Color fundus image · 45° field of view · 2352x1568px — 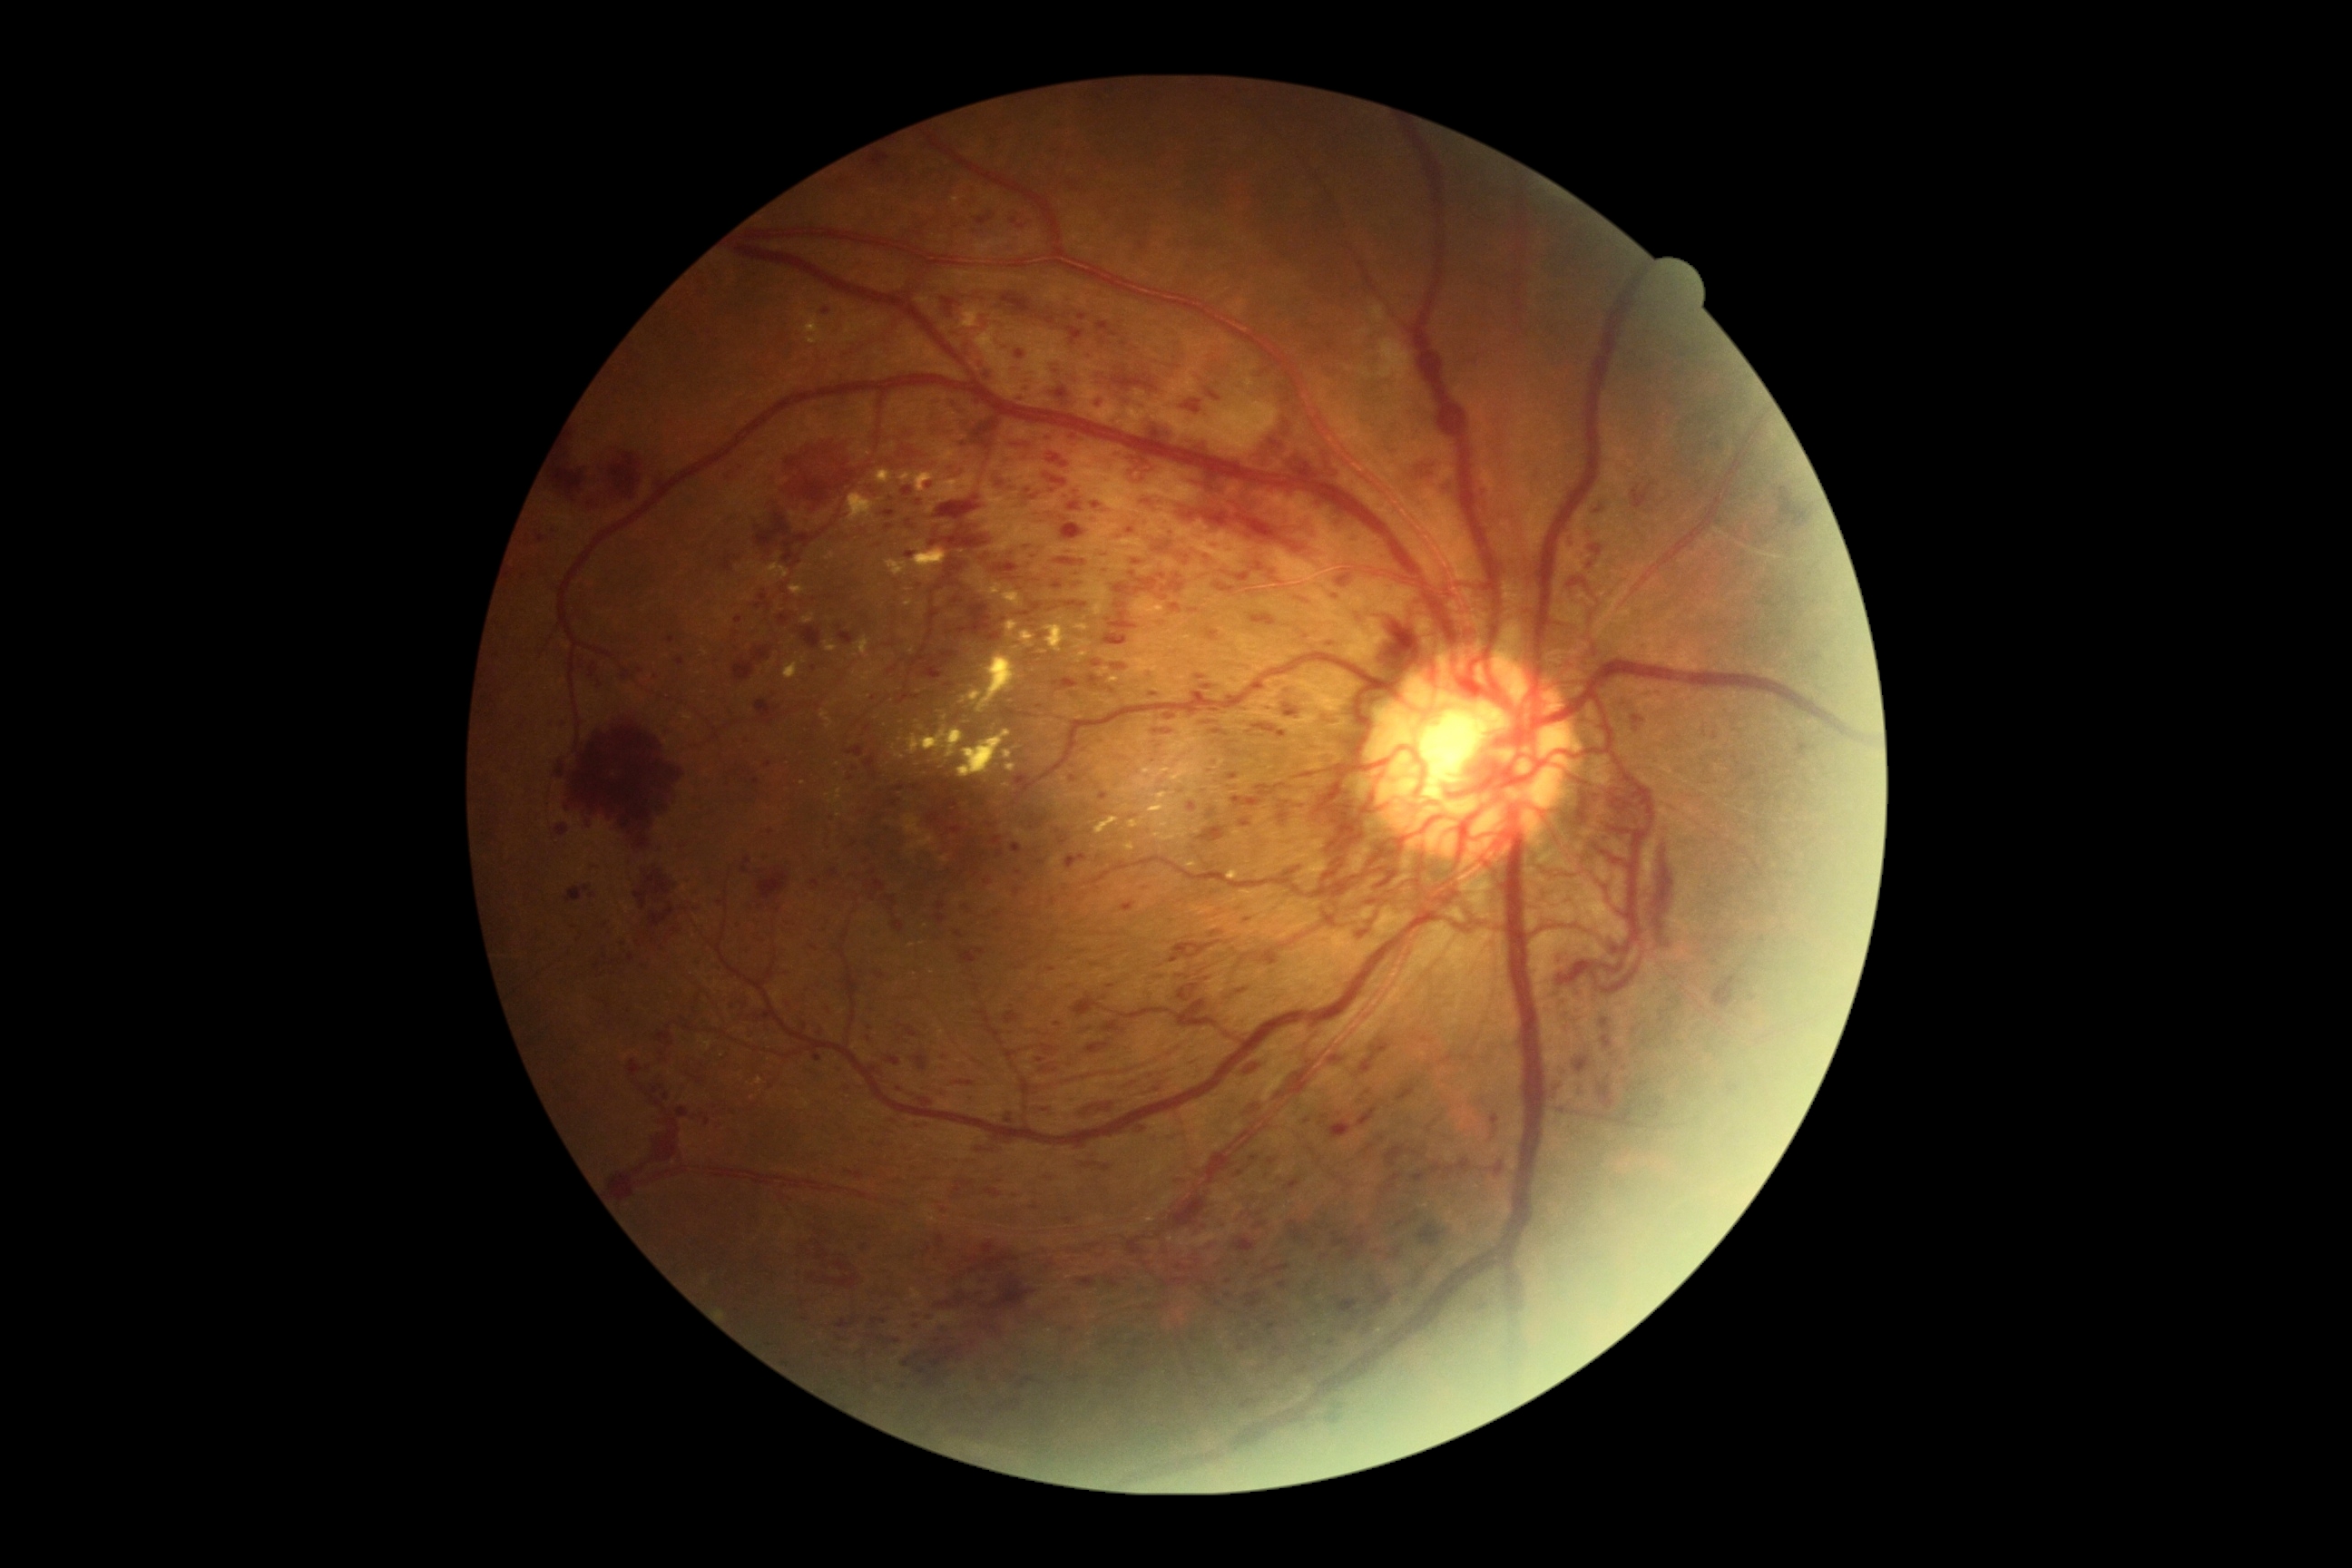

<lesions partial="true">
  <dr_grade>4</dr_grade>
  <he partial="true">[x1=1251, y1=614, x2=1277, y2=627] | [x1=945, y1=556, x2=972, y2=589] | [x1=1244, y1=1101, x2=1262, y2=1113] | [x1=1298, y1=598, x2=1309, y2=607] | [x1=1387, y1=1248, x2=1402, y2=1260] | [x1=553, y1=456, x2=589, y2=495] | [x1=883, y1=896, x2=897, y2=906] | [x1=1206, y1=808, x2=1217, y2=819] | [x1=1255, y1=685, x2=1264, y2=692] | [x1=1008, y1=436, x2=1034, y2=451] | [x1=901, y1=1338, x2=970, y2=1387] | [x1=808, y1=1273, x2=819, y2=1280] | [x1=1199, y1=681, x2=1224, y2=692] | [x1=1108, y1=1026, x2=1117, y2=1032] | [x1=1162, y1=574, x2=1186, y2=594] | [x1=756, y1=700, x2=779, y2=725]</he>
  <he_small>(864; 1248) | (1037; 581) | (985; 1282)</he_small>
</lesions>